Infant wide-field fundus photograph.
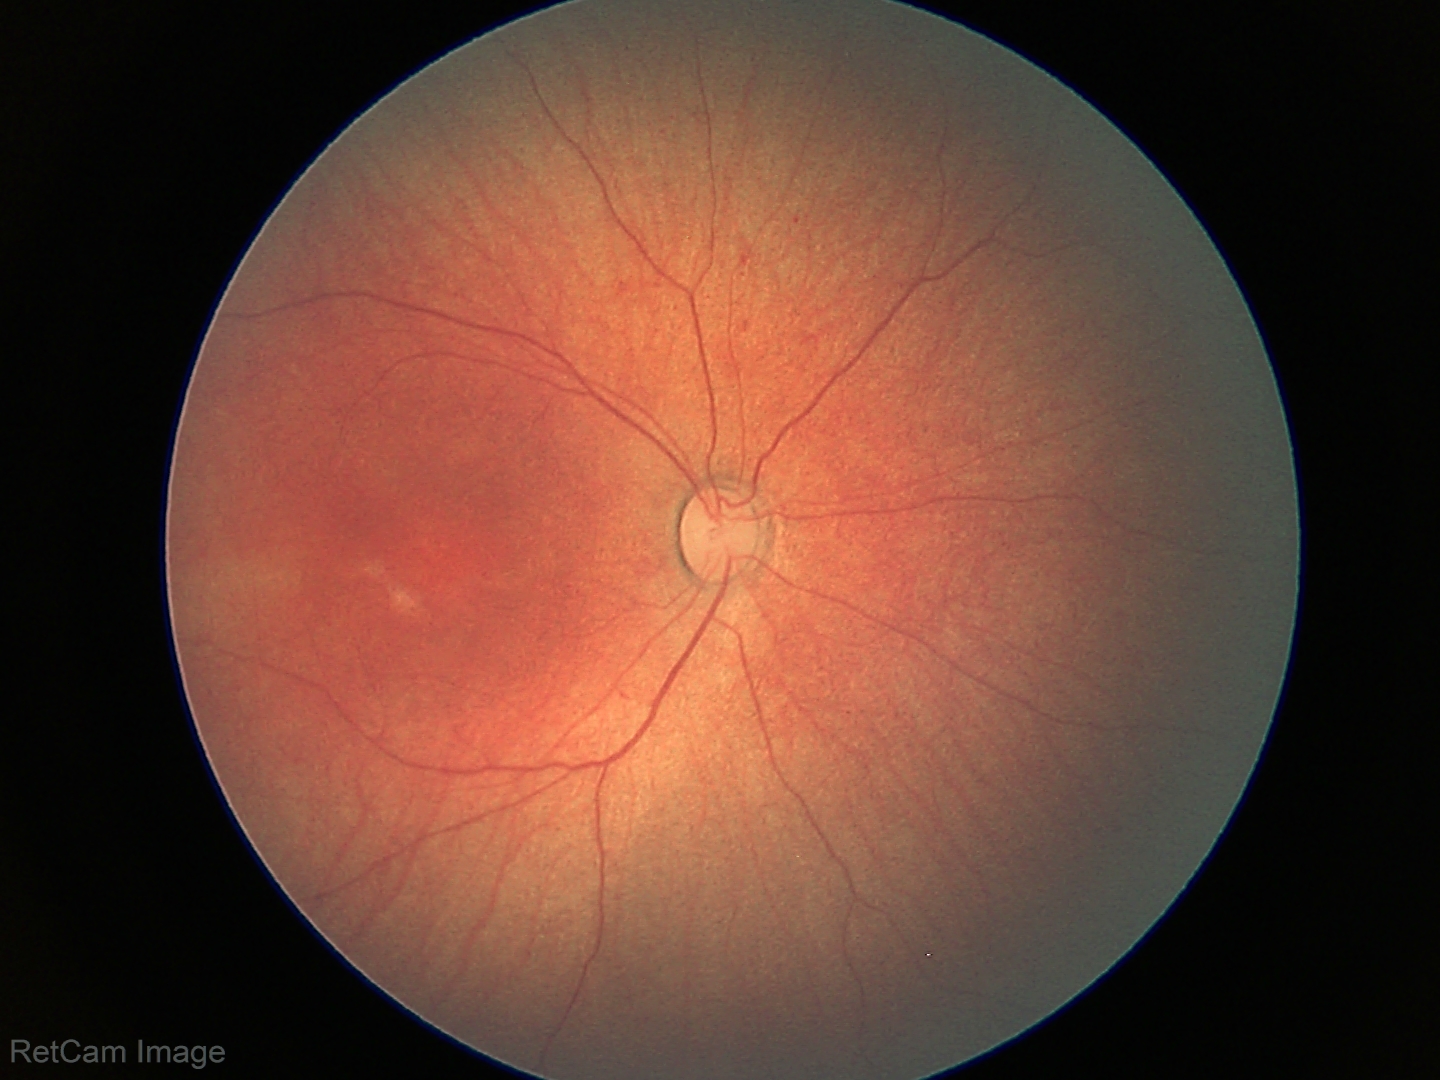
Finding: no pathology identified.